45-degree field of view. Acquired with a NIDEK AFC-230:
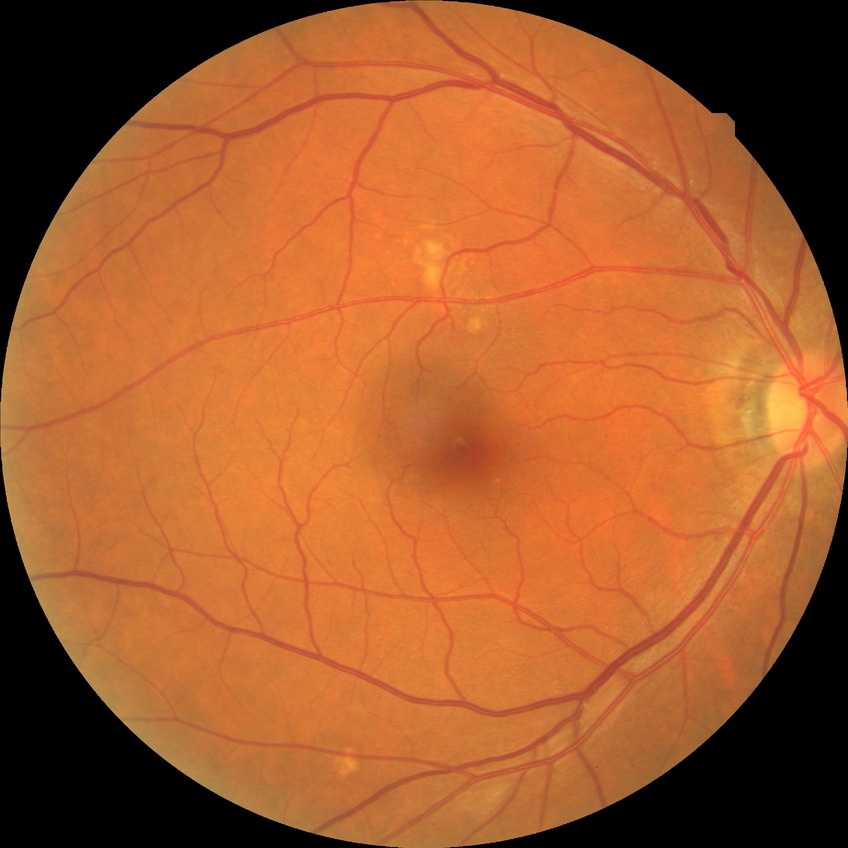

Retinopathy stage: no diabetic retinopathy.